1920 x 1440 pixels:
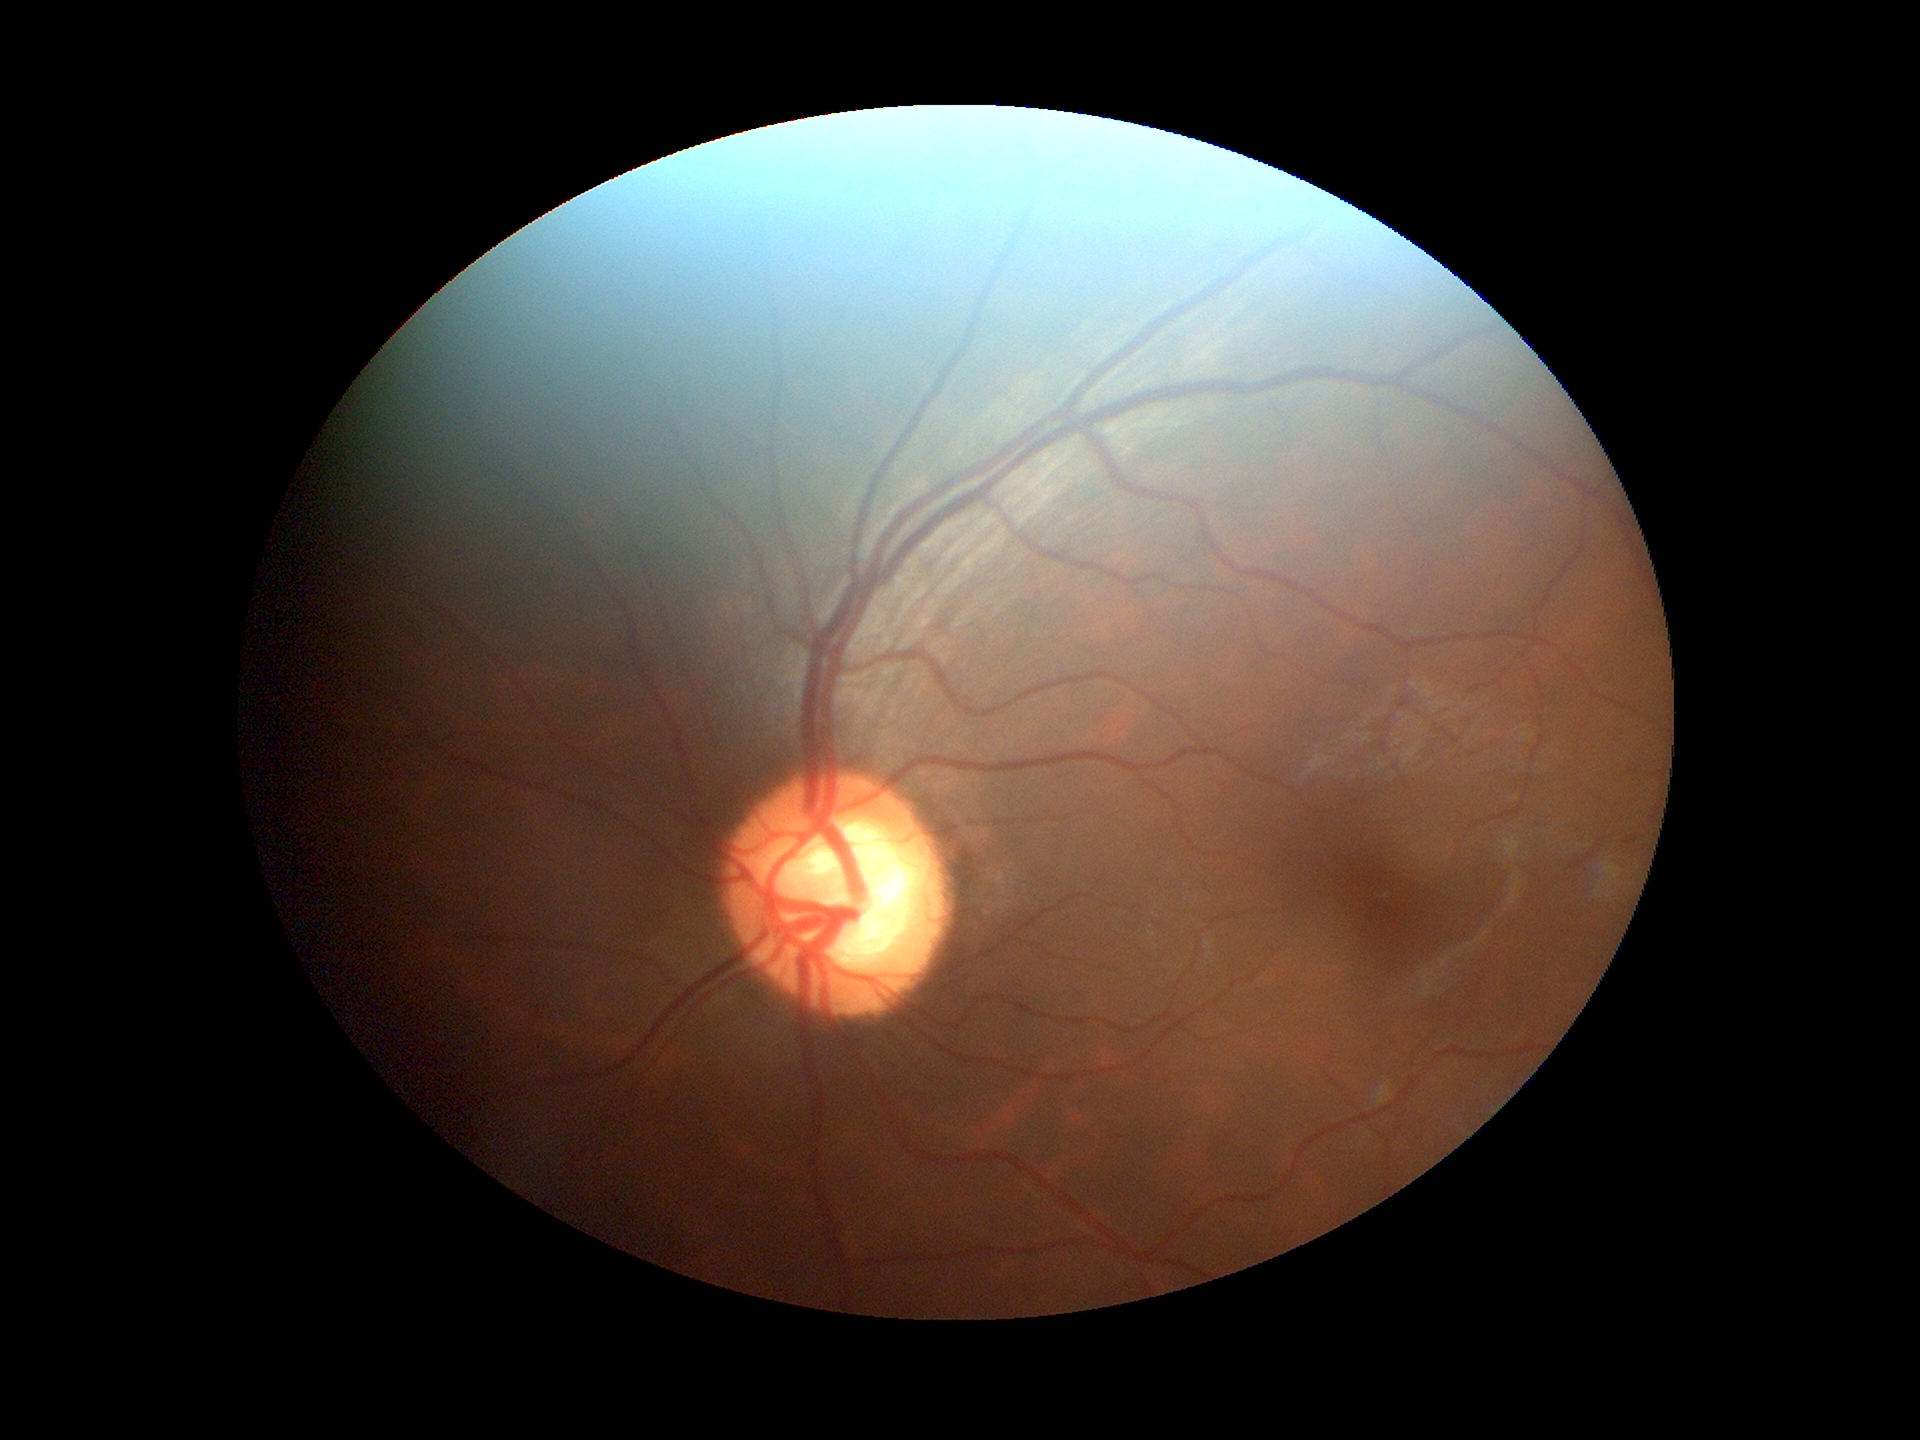 Glaucoma impression: suspicious
area CDR (ACDR): 0.43
vertical cup-disc ratio (VCDR): 0.65
horizontal CDR (HCDR): 0.66